Color fundus image; 240 x 240 pixels
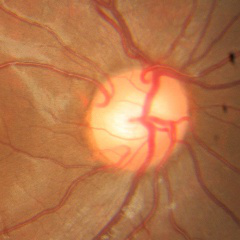 Optic disc appearance consistent with no glaucoma.